45° field of view; nonmydriatic; color fundus photograph; 848x848.
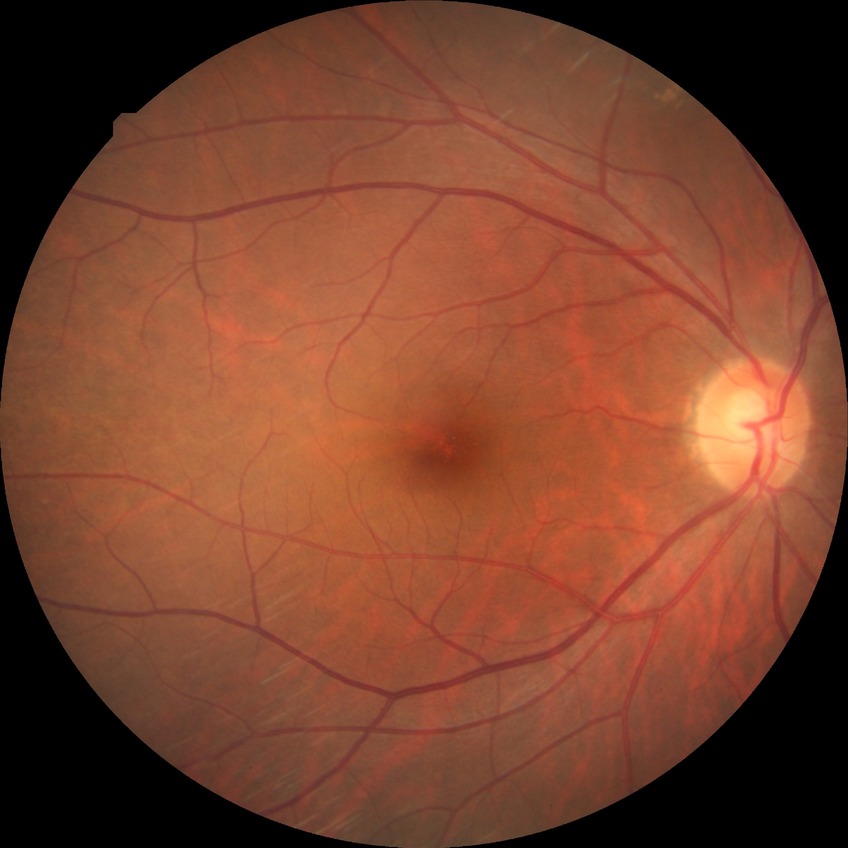

diabetic retinopathy (DR)=no diabetic retinopathy (NDR).